Davis DR grading · 45° FOV: 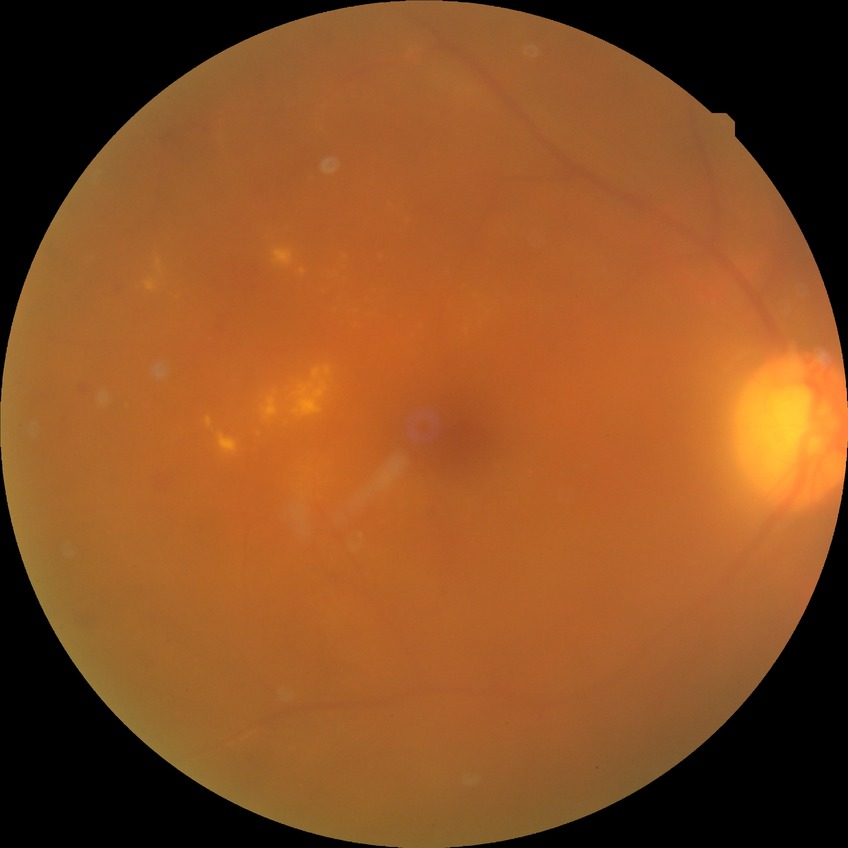 DR class = non-proliferative diabetic retinopathy
diabetic retinopathy (DR) = simple diabetic retinopathy (SDR)